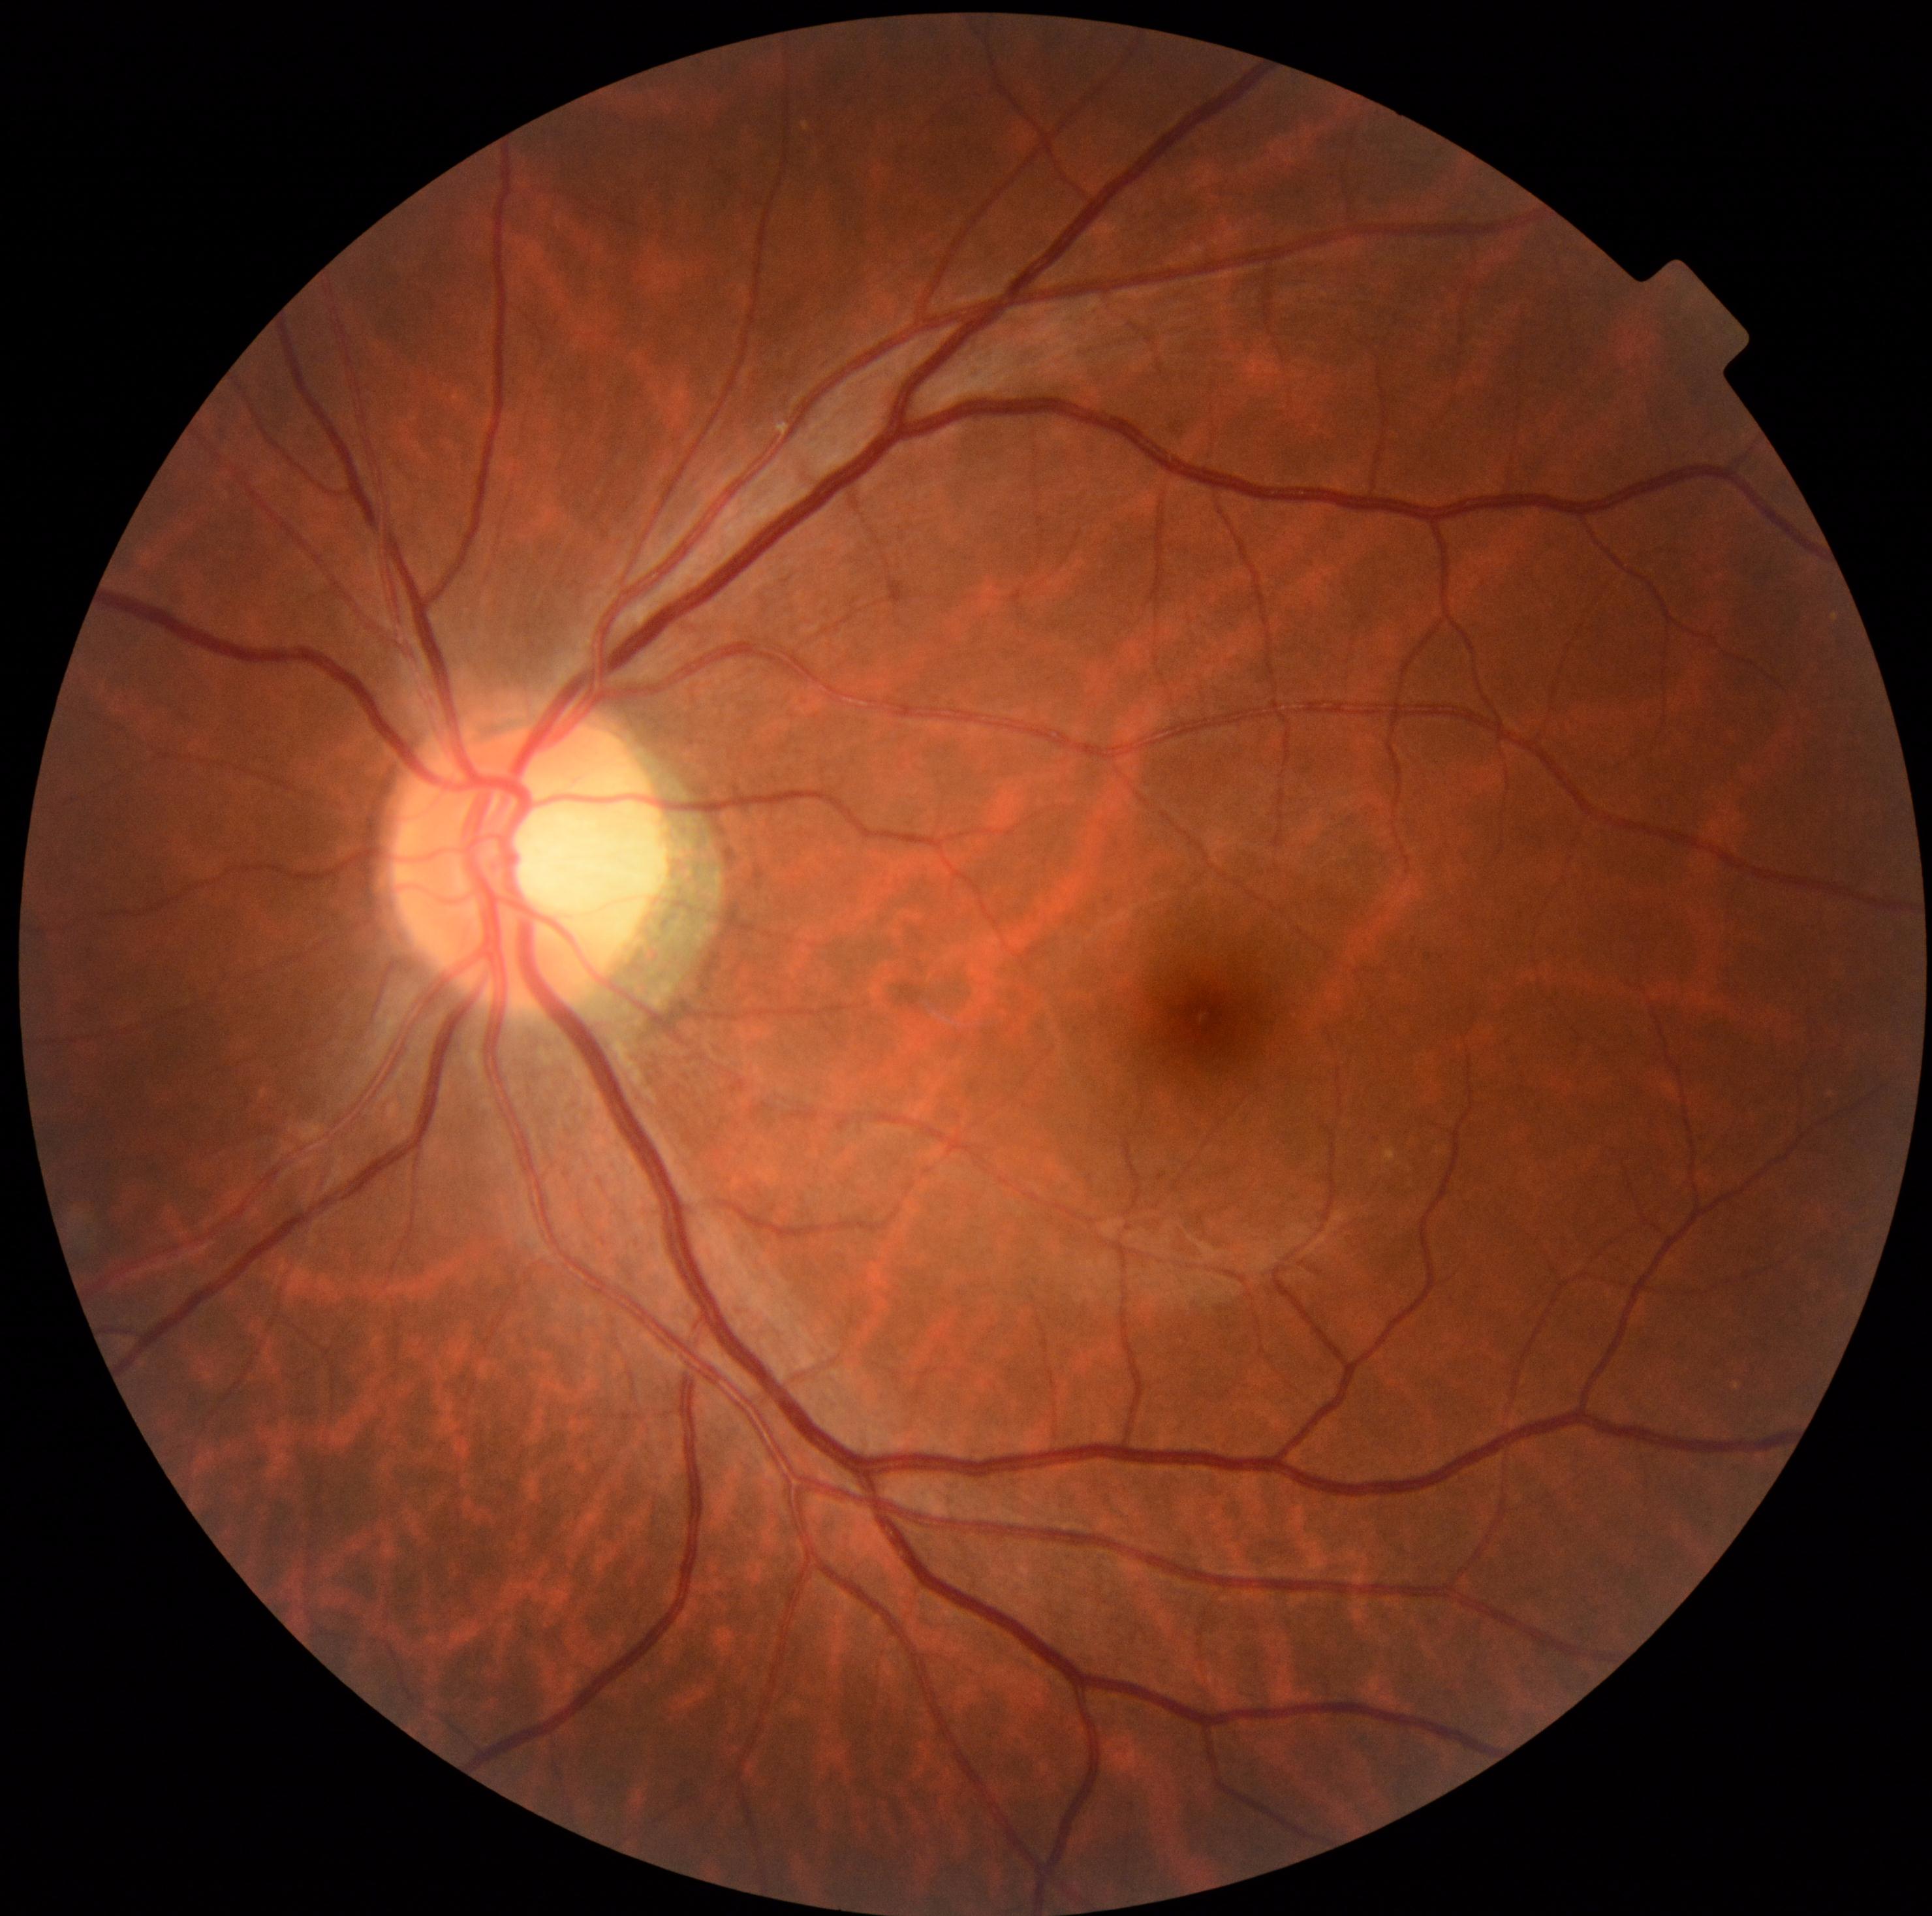

Diabetic retinopathy: 0. No diabetic retinal disease findings.